Topcon TRC-NW8, 50-degree field of view, 1932x1932px
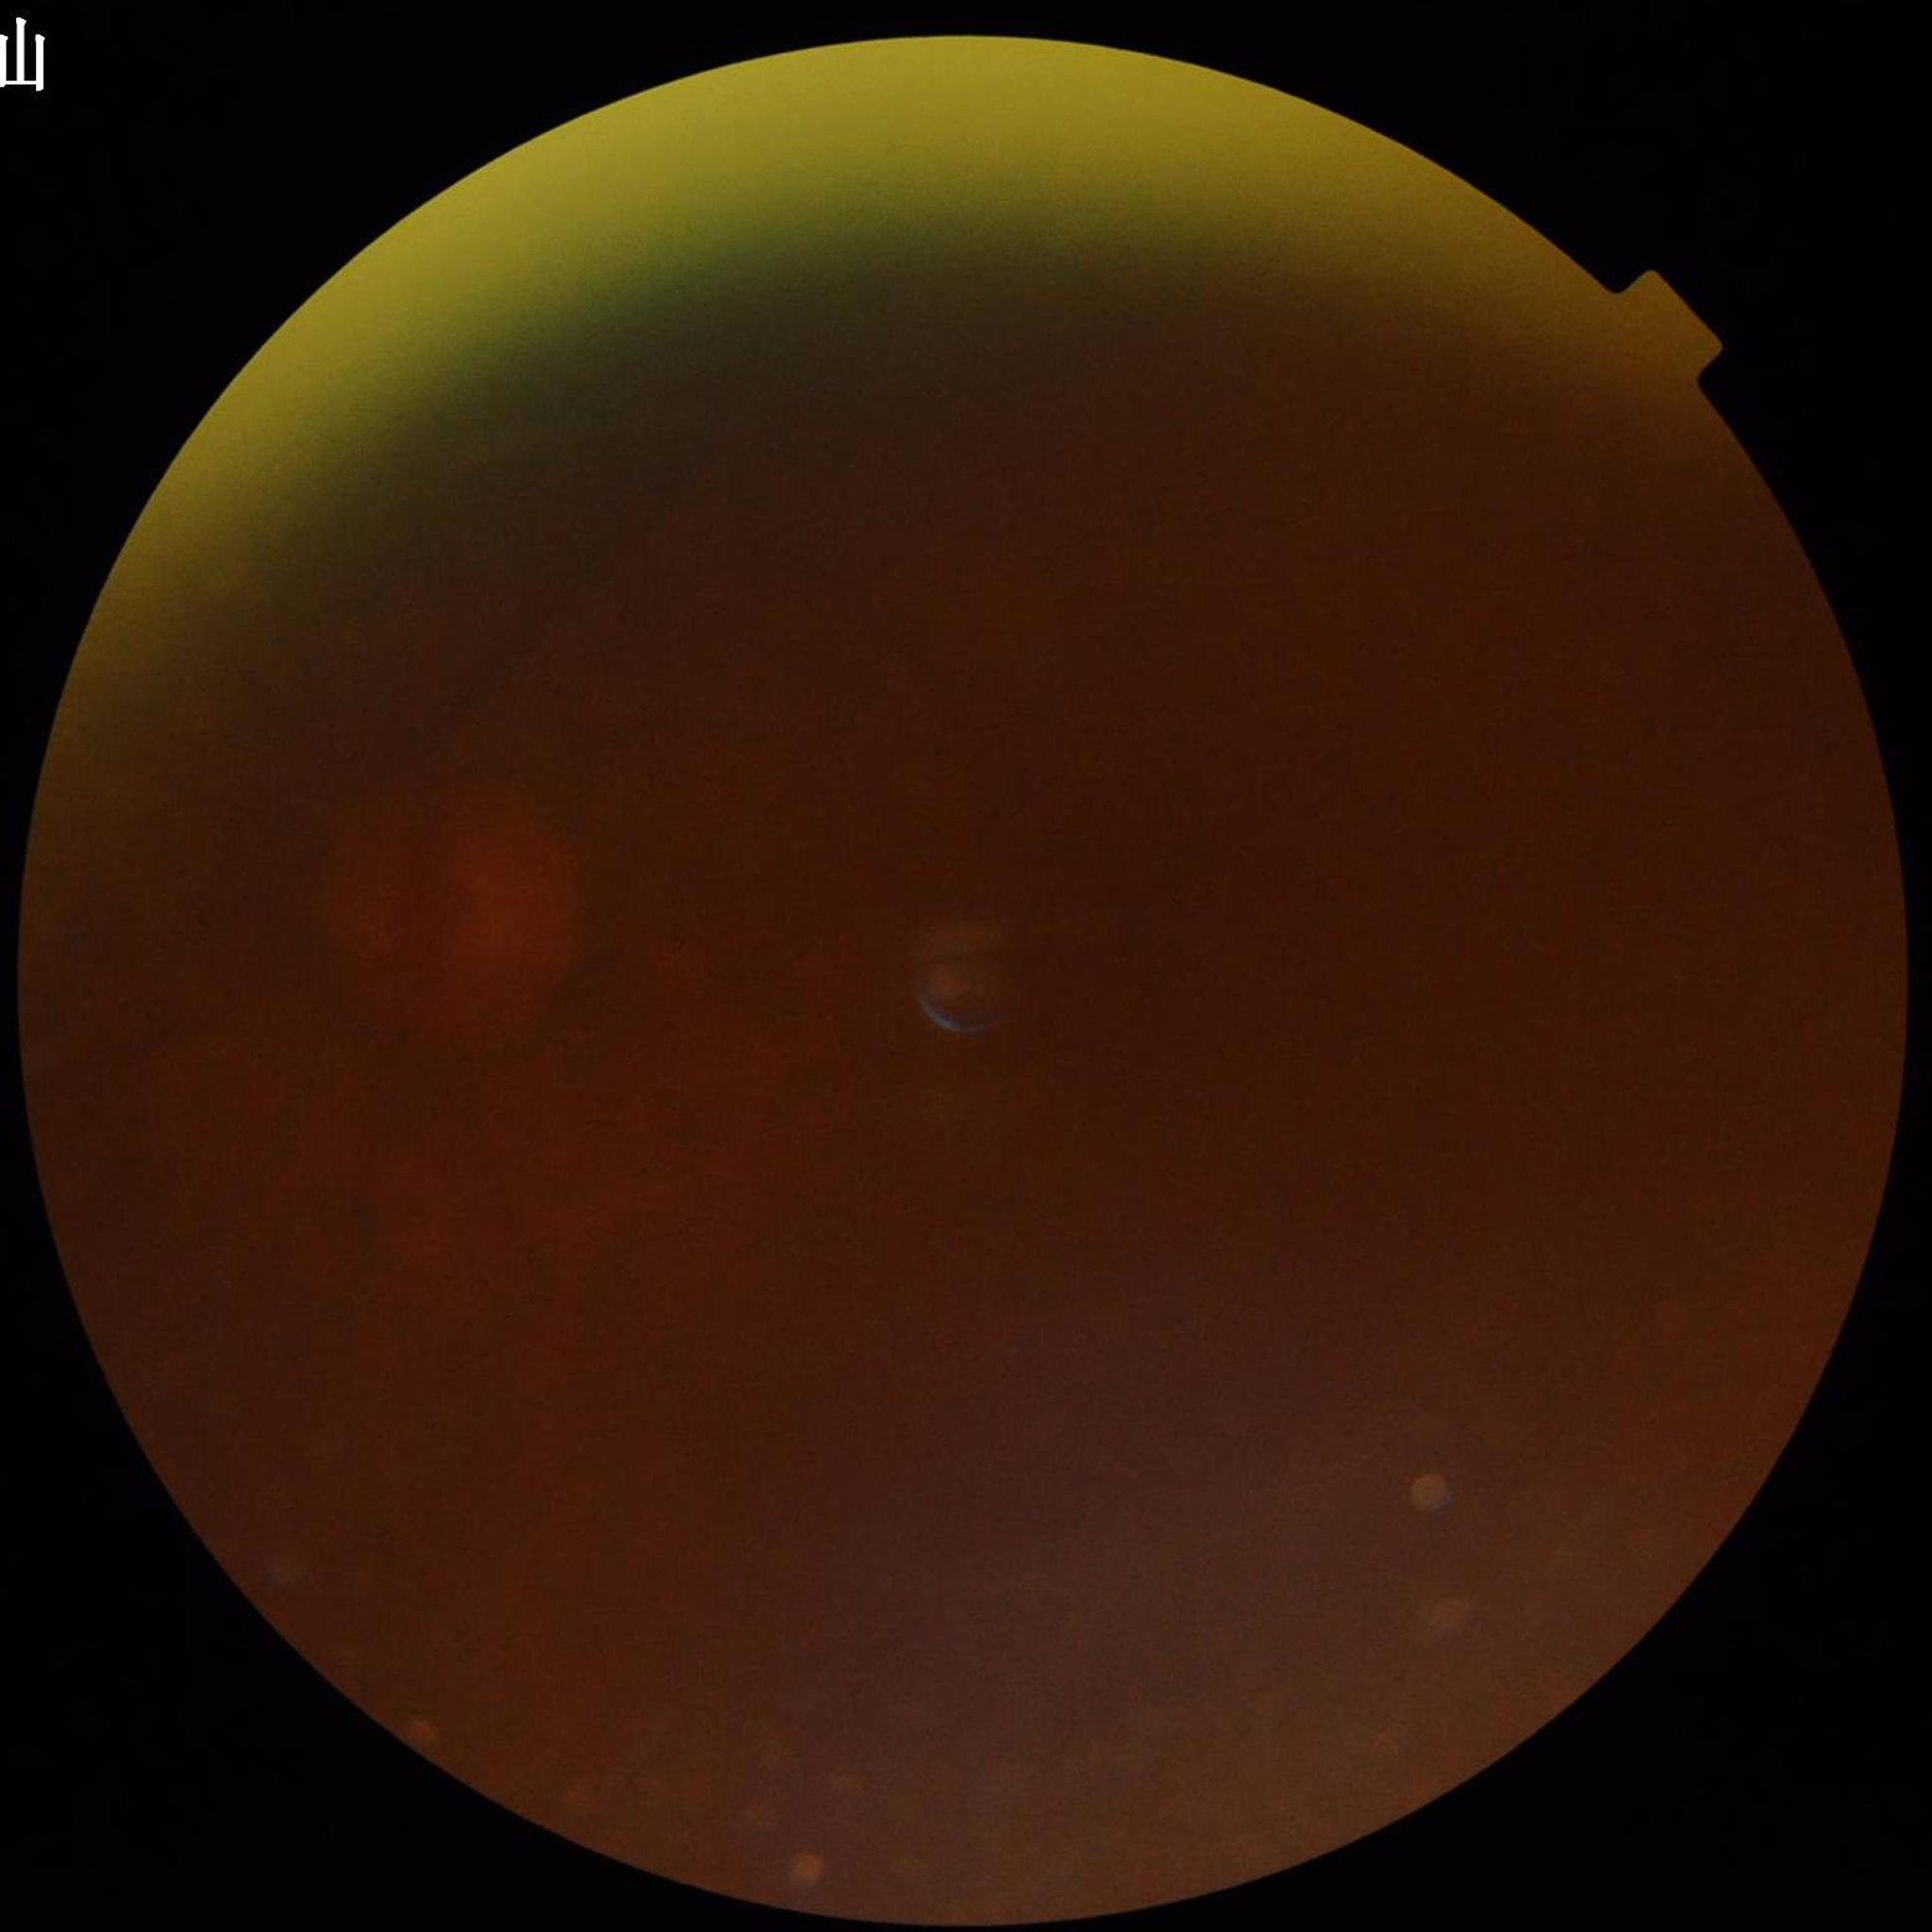 Fundus image of an eye with glaucoma. Automated quality assessment: poor — blur, illumination/color distortion, low contrast.